Modified Davis classification
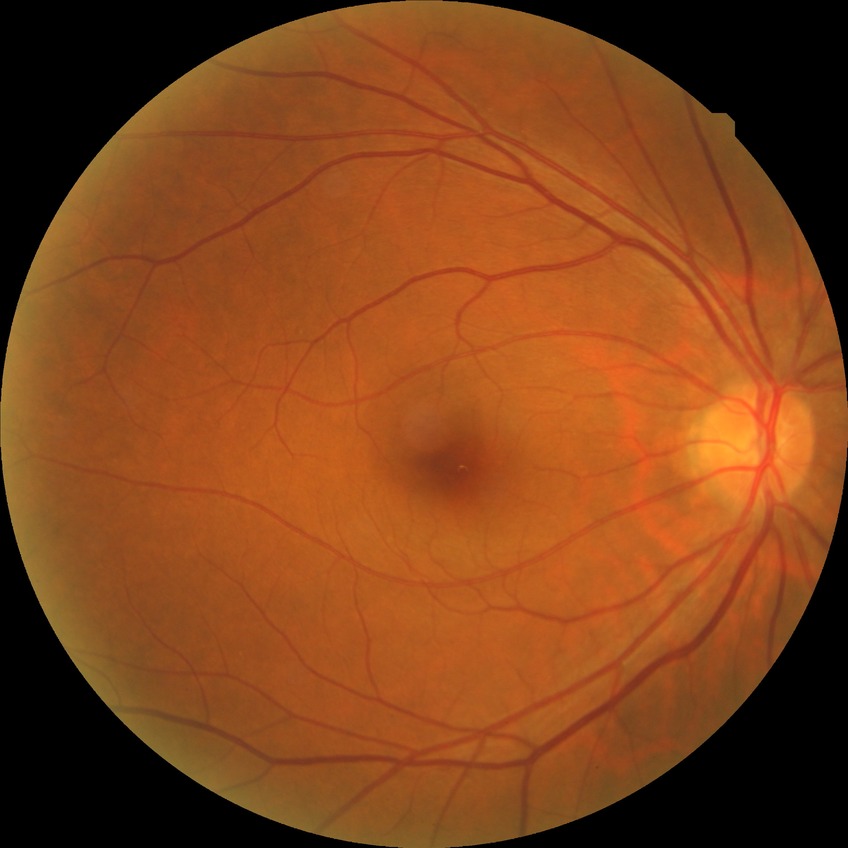 diabetic retinopathy stage: no diabetic retinopathy.